45° FOV, 2048 by 1536 pixels — 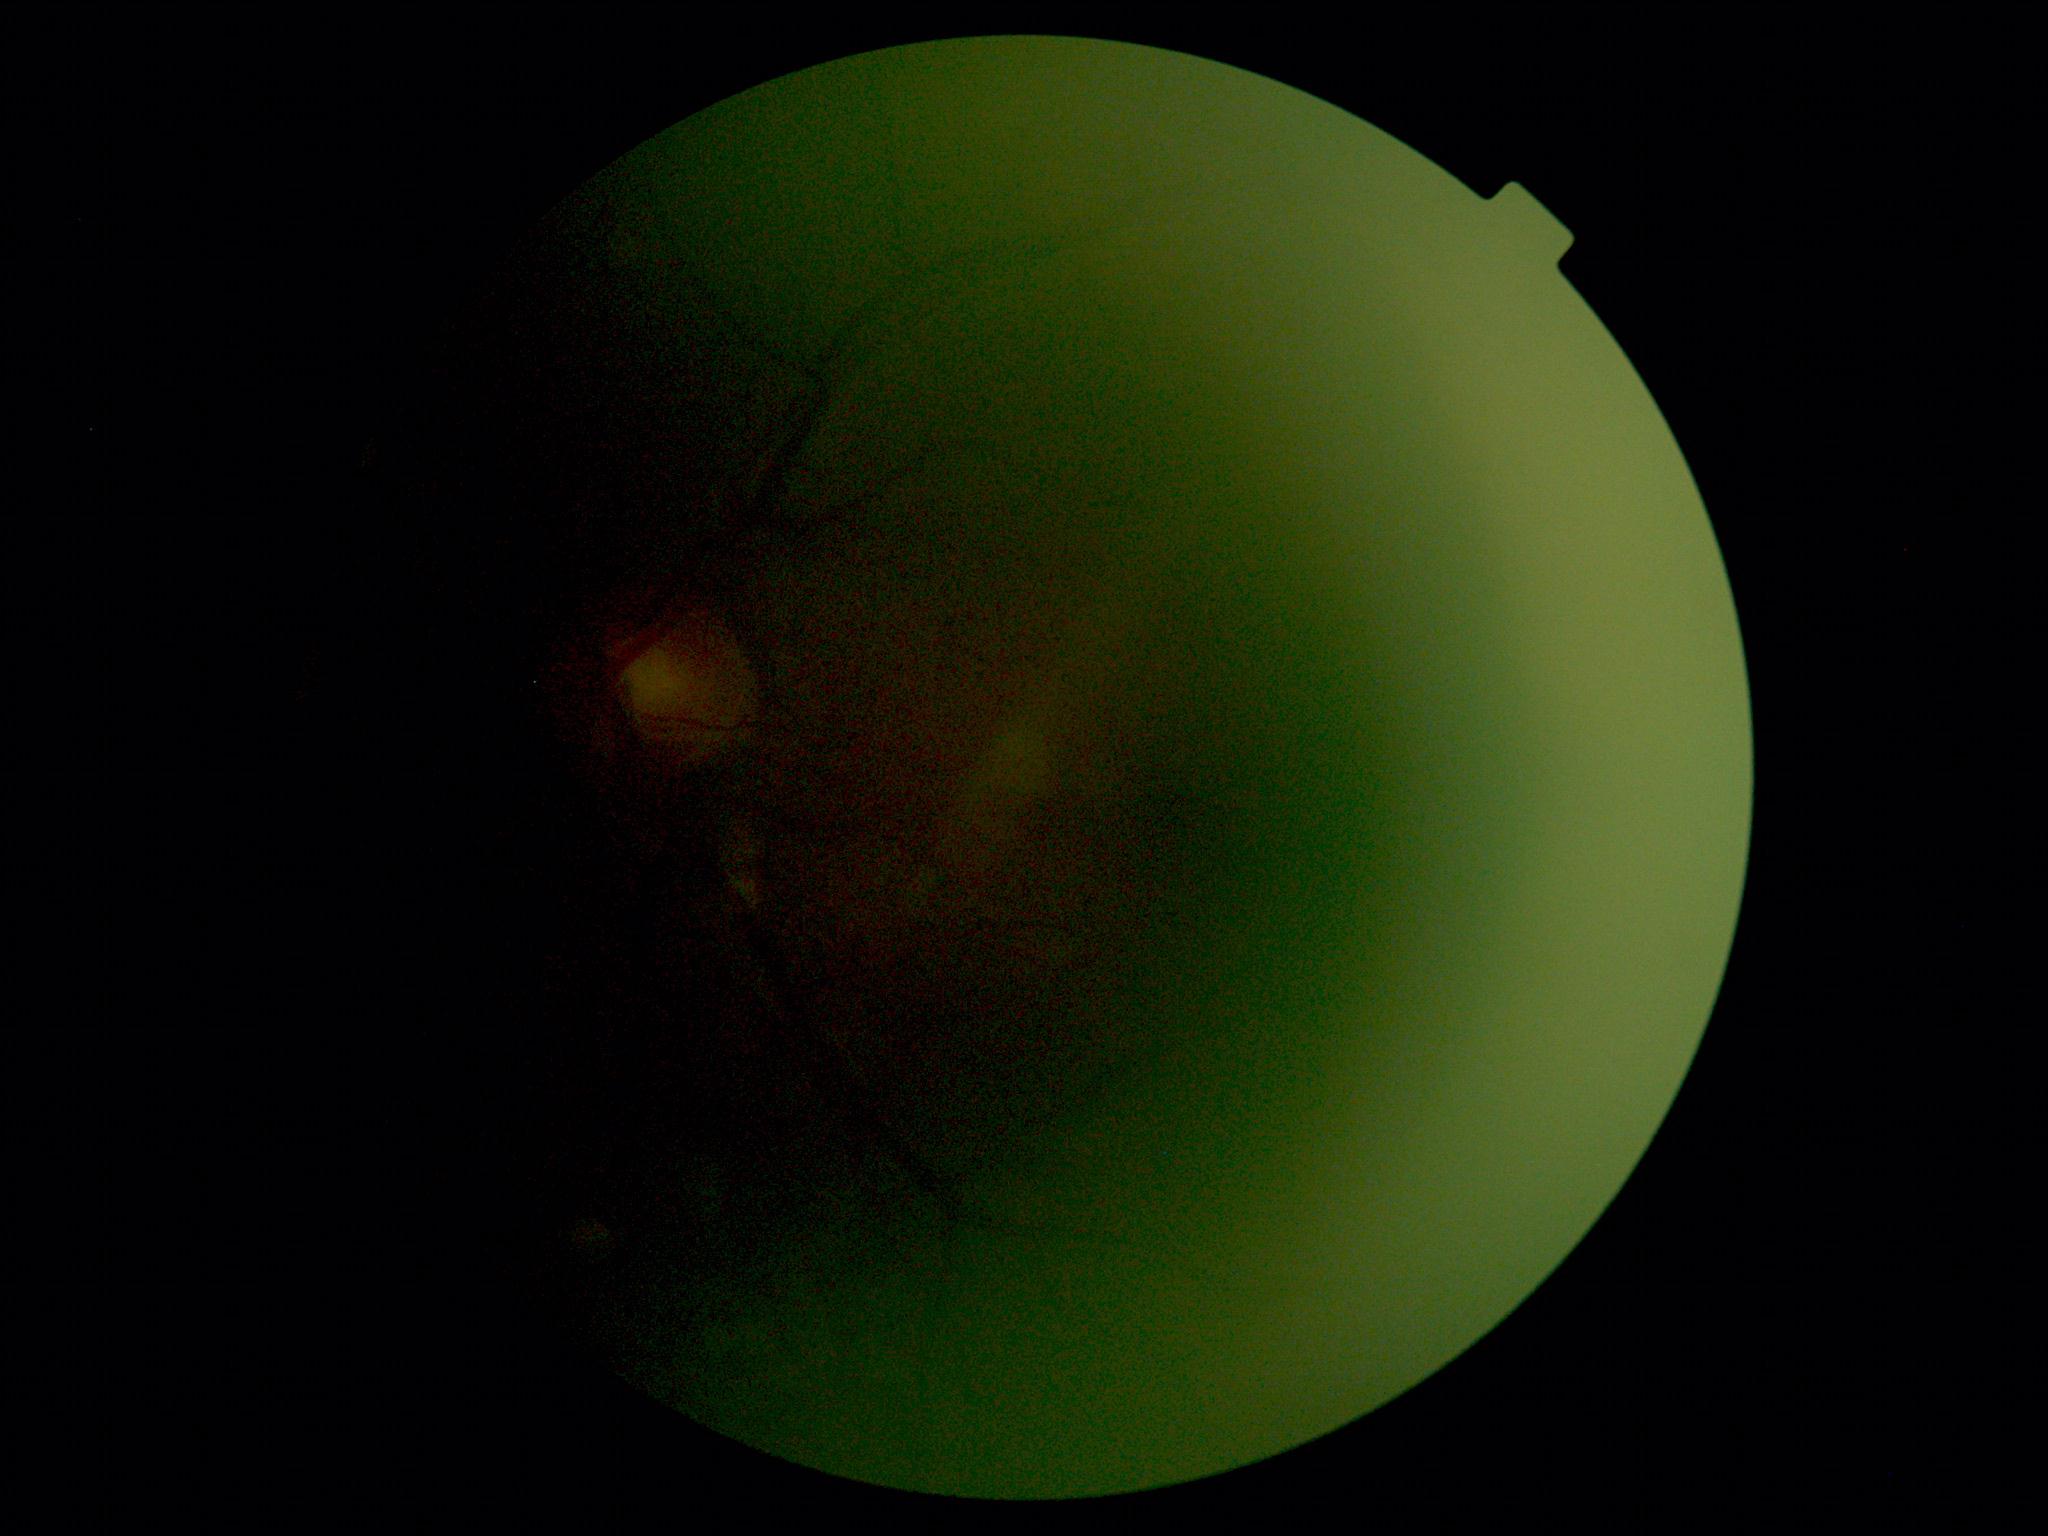

- DR stage — ungradable due to poor image quality